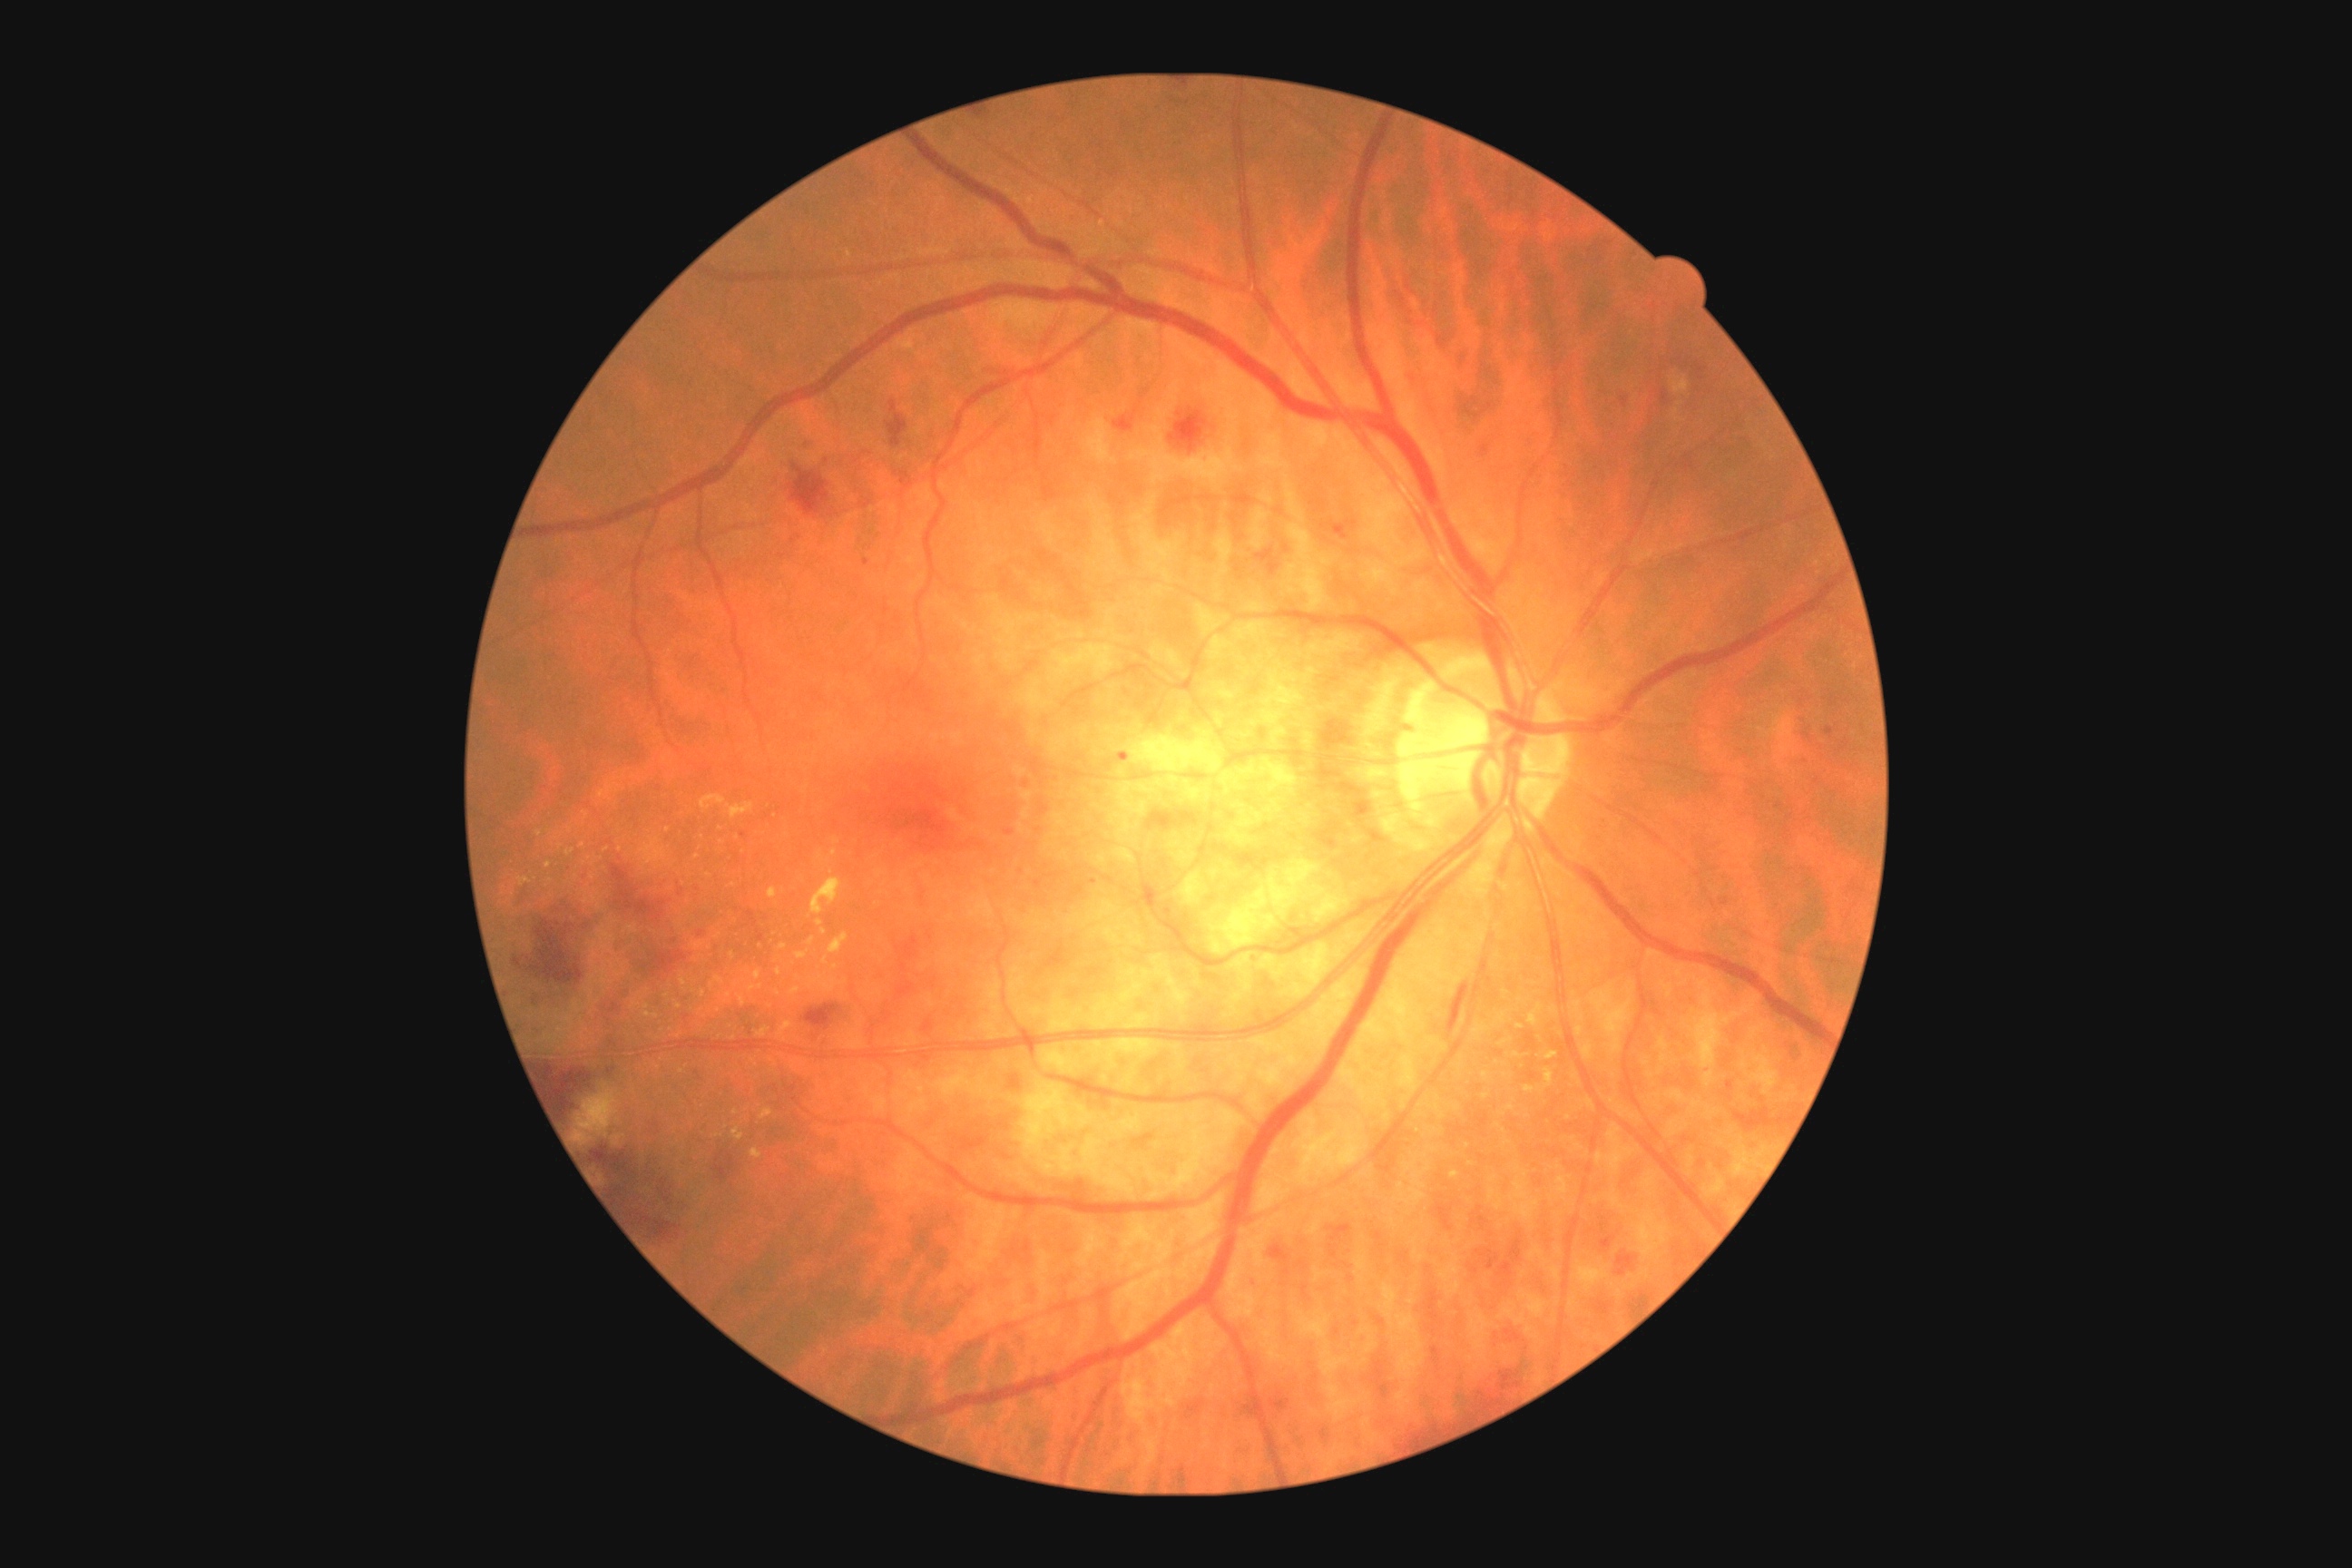

{"dr_grade": "grade 2", "dr_category": "non-proliferative diabetic retinopathy"}